Acquired with a Remidio FOP fundus camera:
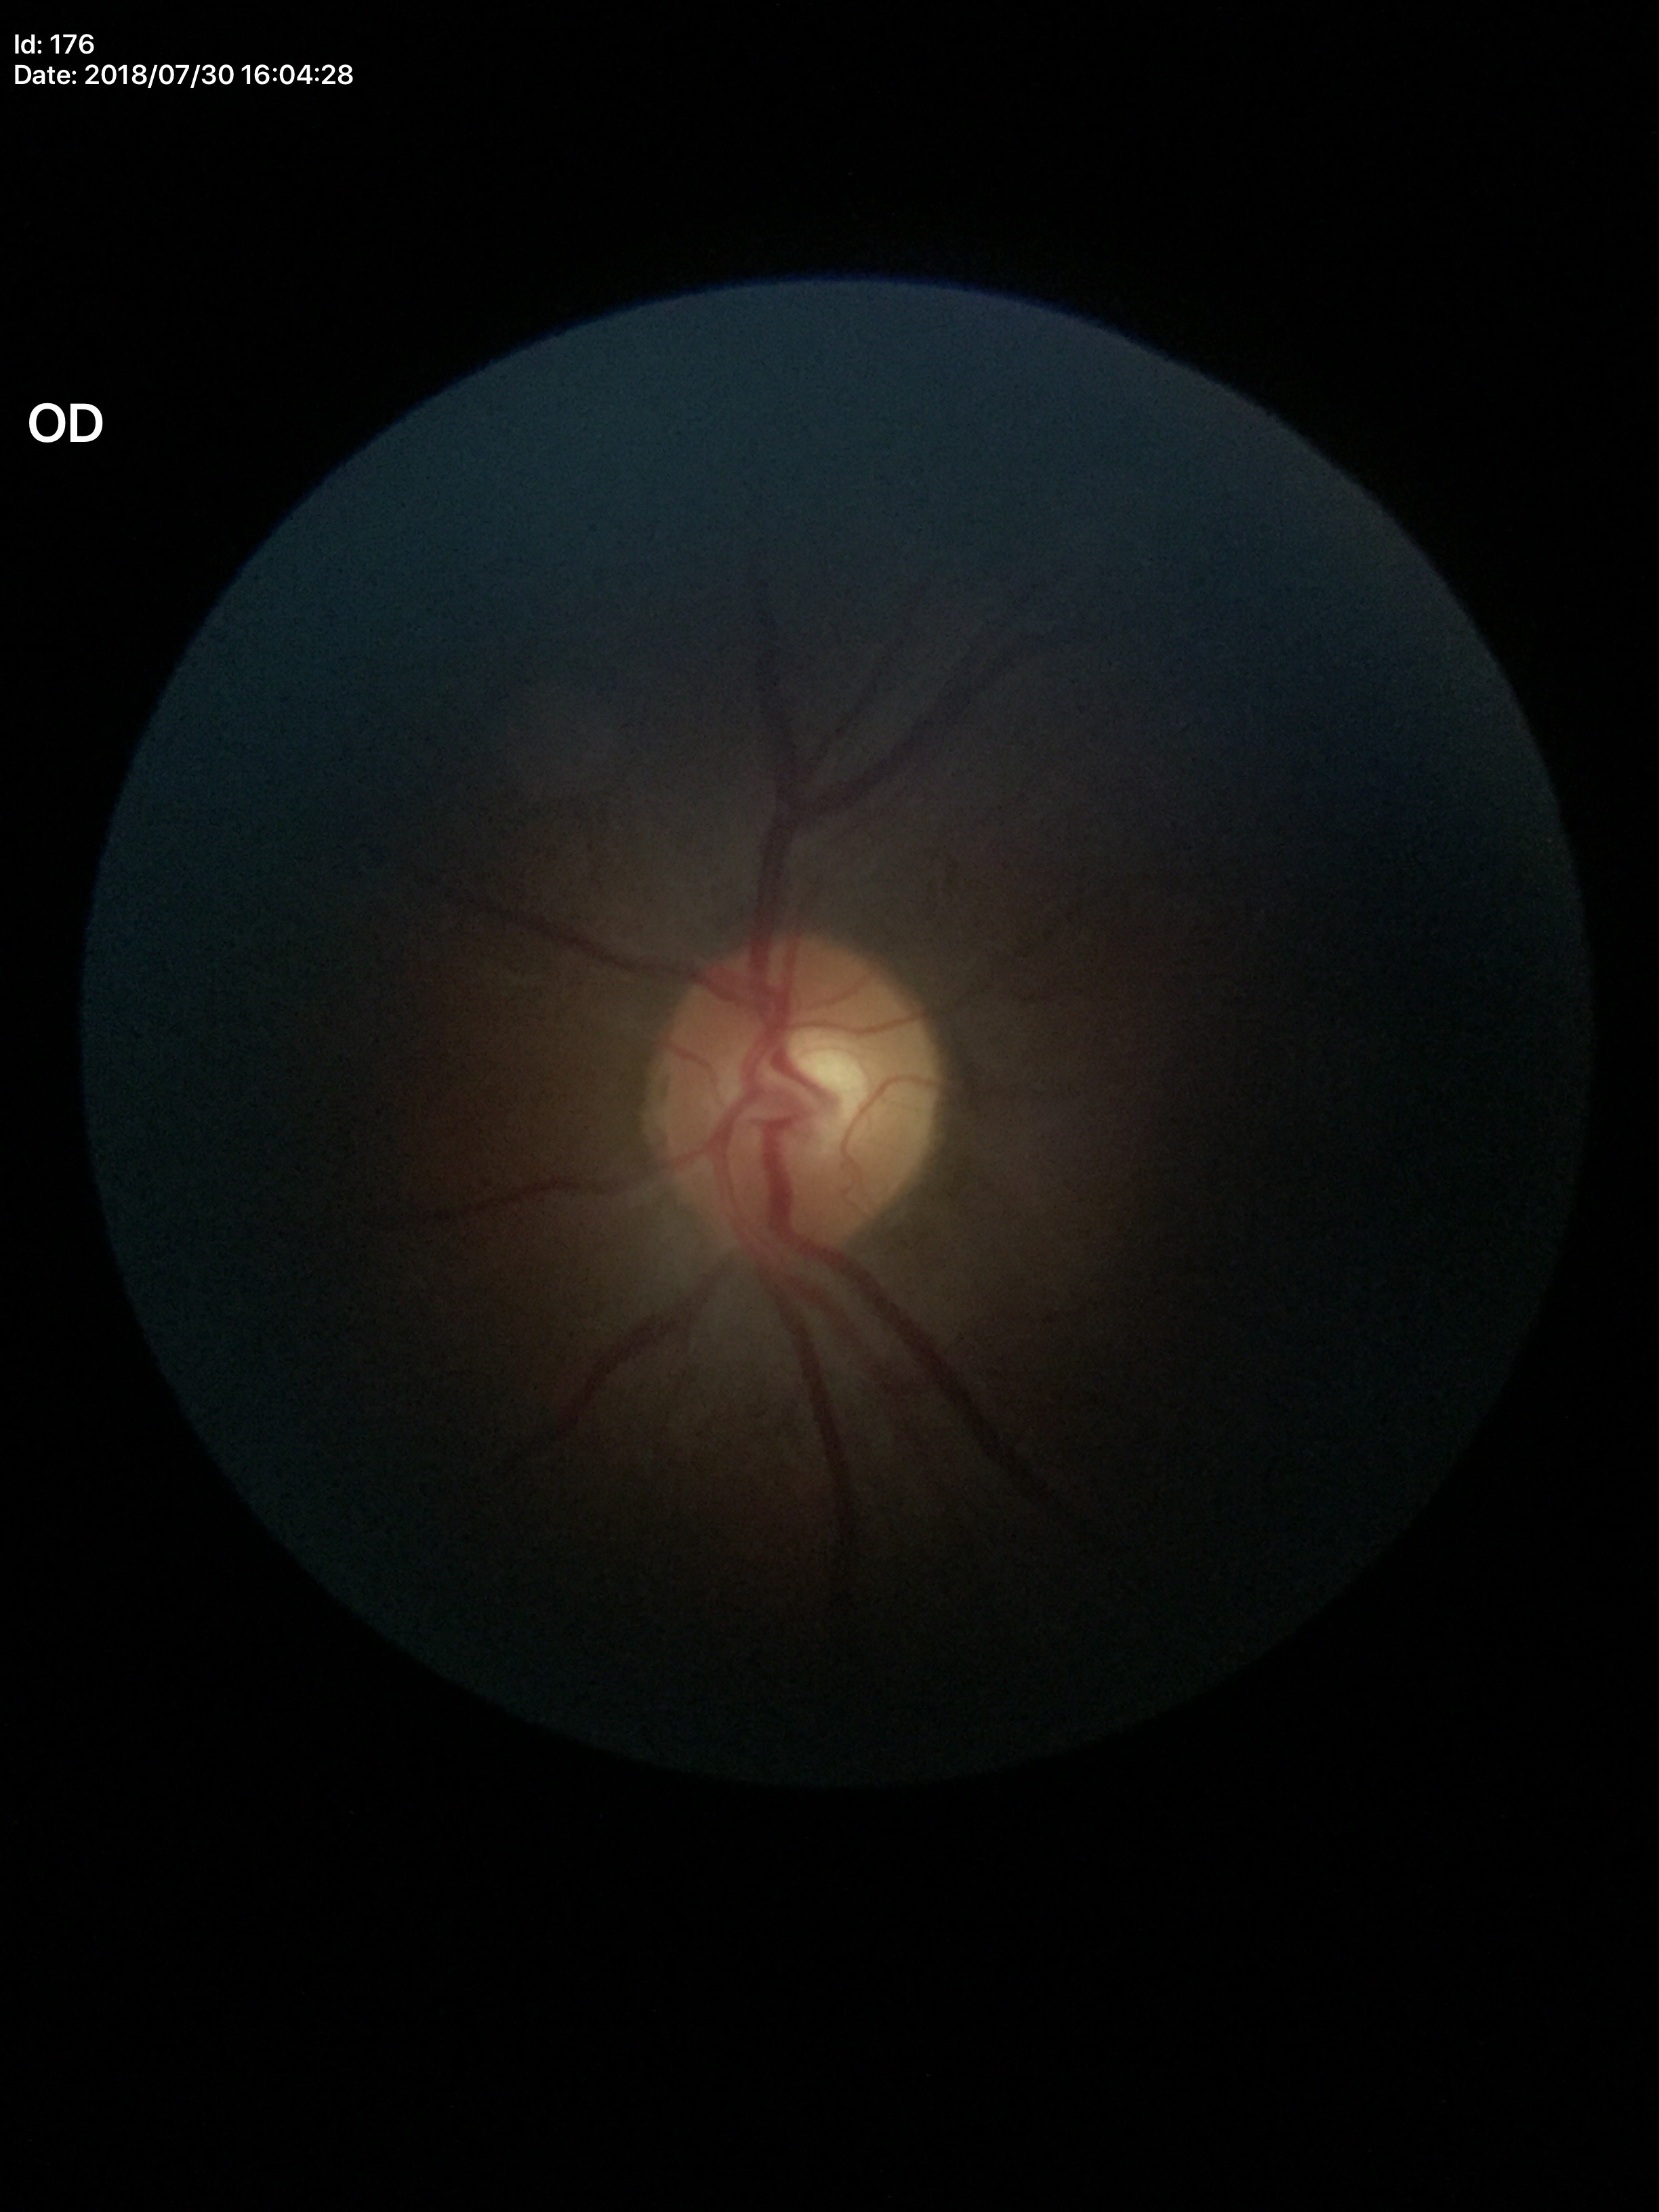

Not suspicious for glaucoma. Vertical C/D ratio is 0.51. Horizontal cup-to-disc ratio: 0.52.